Camera: Topcon TRC-50DX. Captured after pupil dilation.
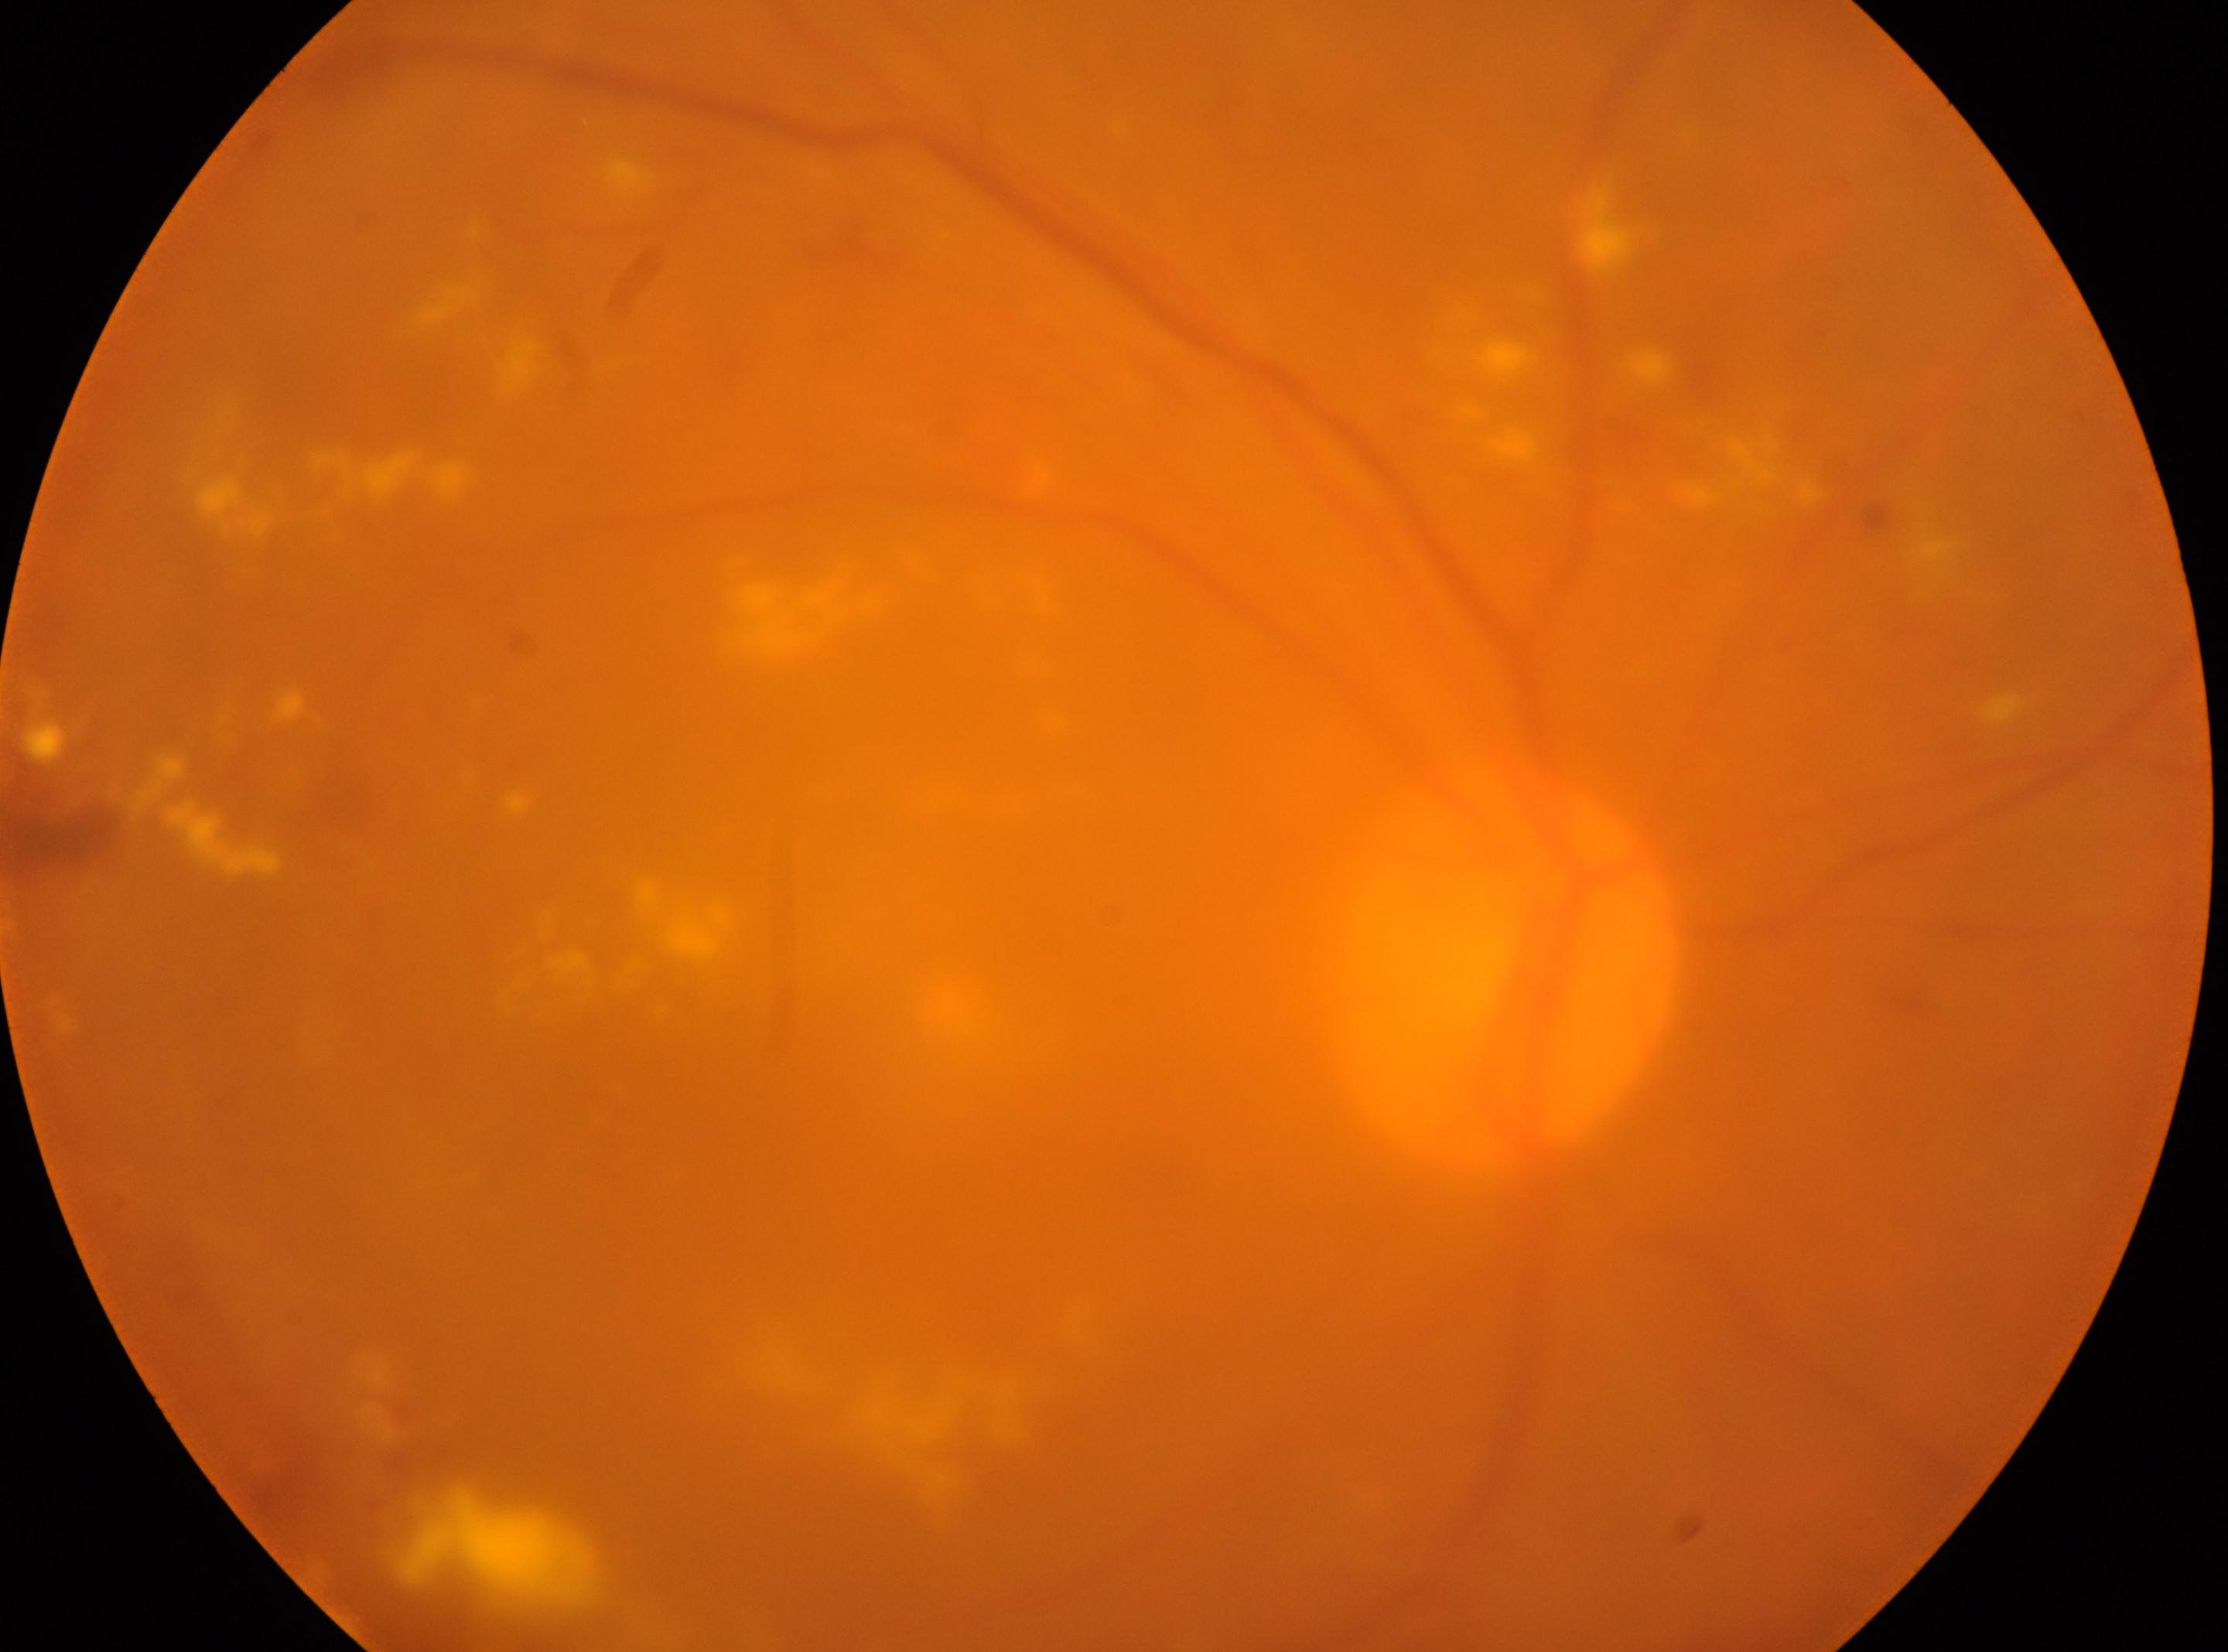

Q: Right or left eye?
A: OD
Q: DR stage?
A: 2/4
Q: Fovea center?
A: [605, 1072]
Q: What disease class is present?
A: non-proliferative diabetic retinopathy
Q: Optic disc center?
A: [1505, 974]